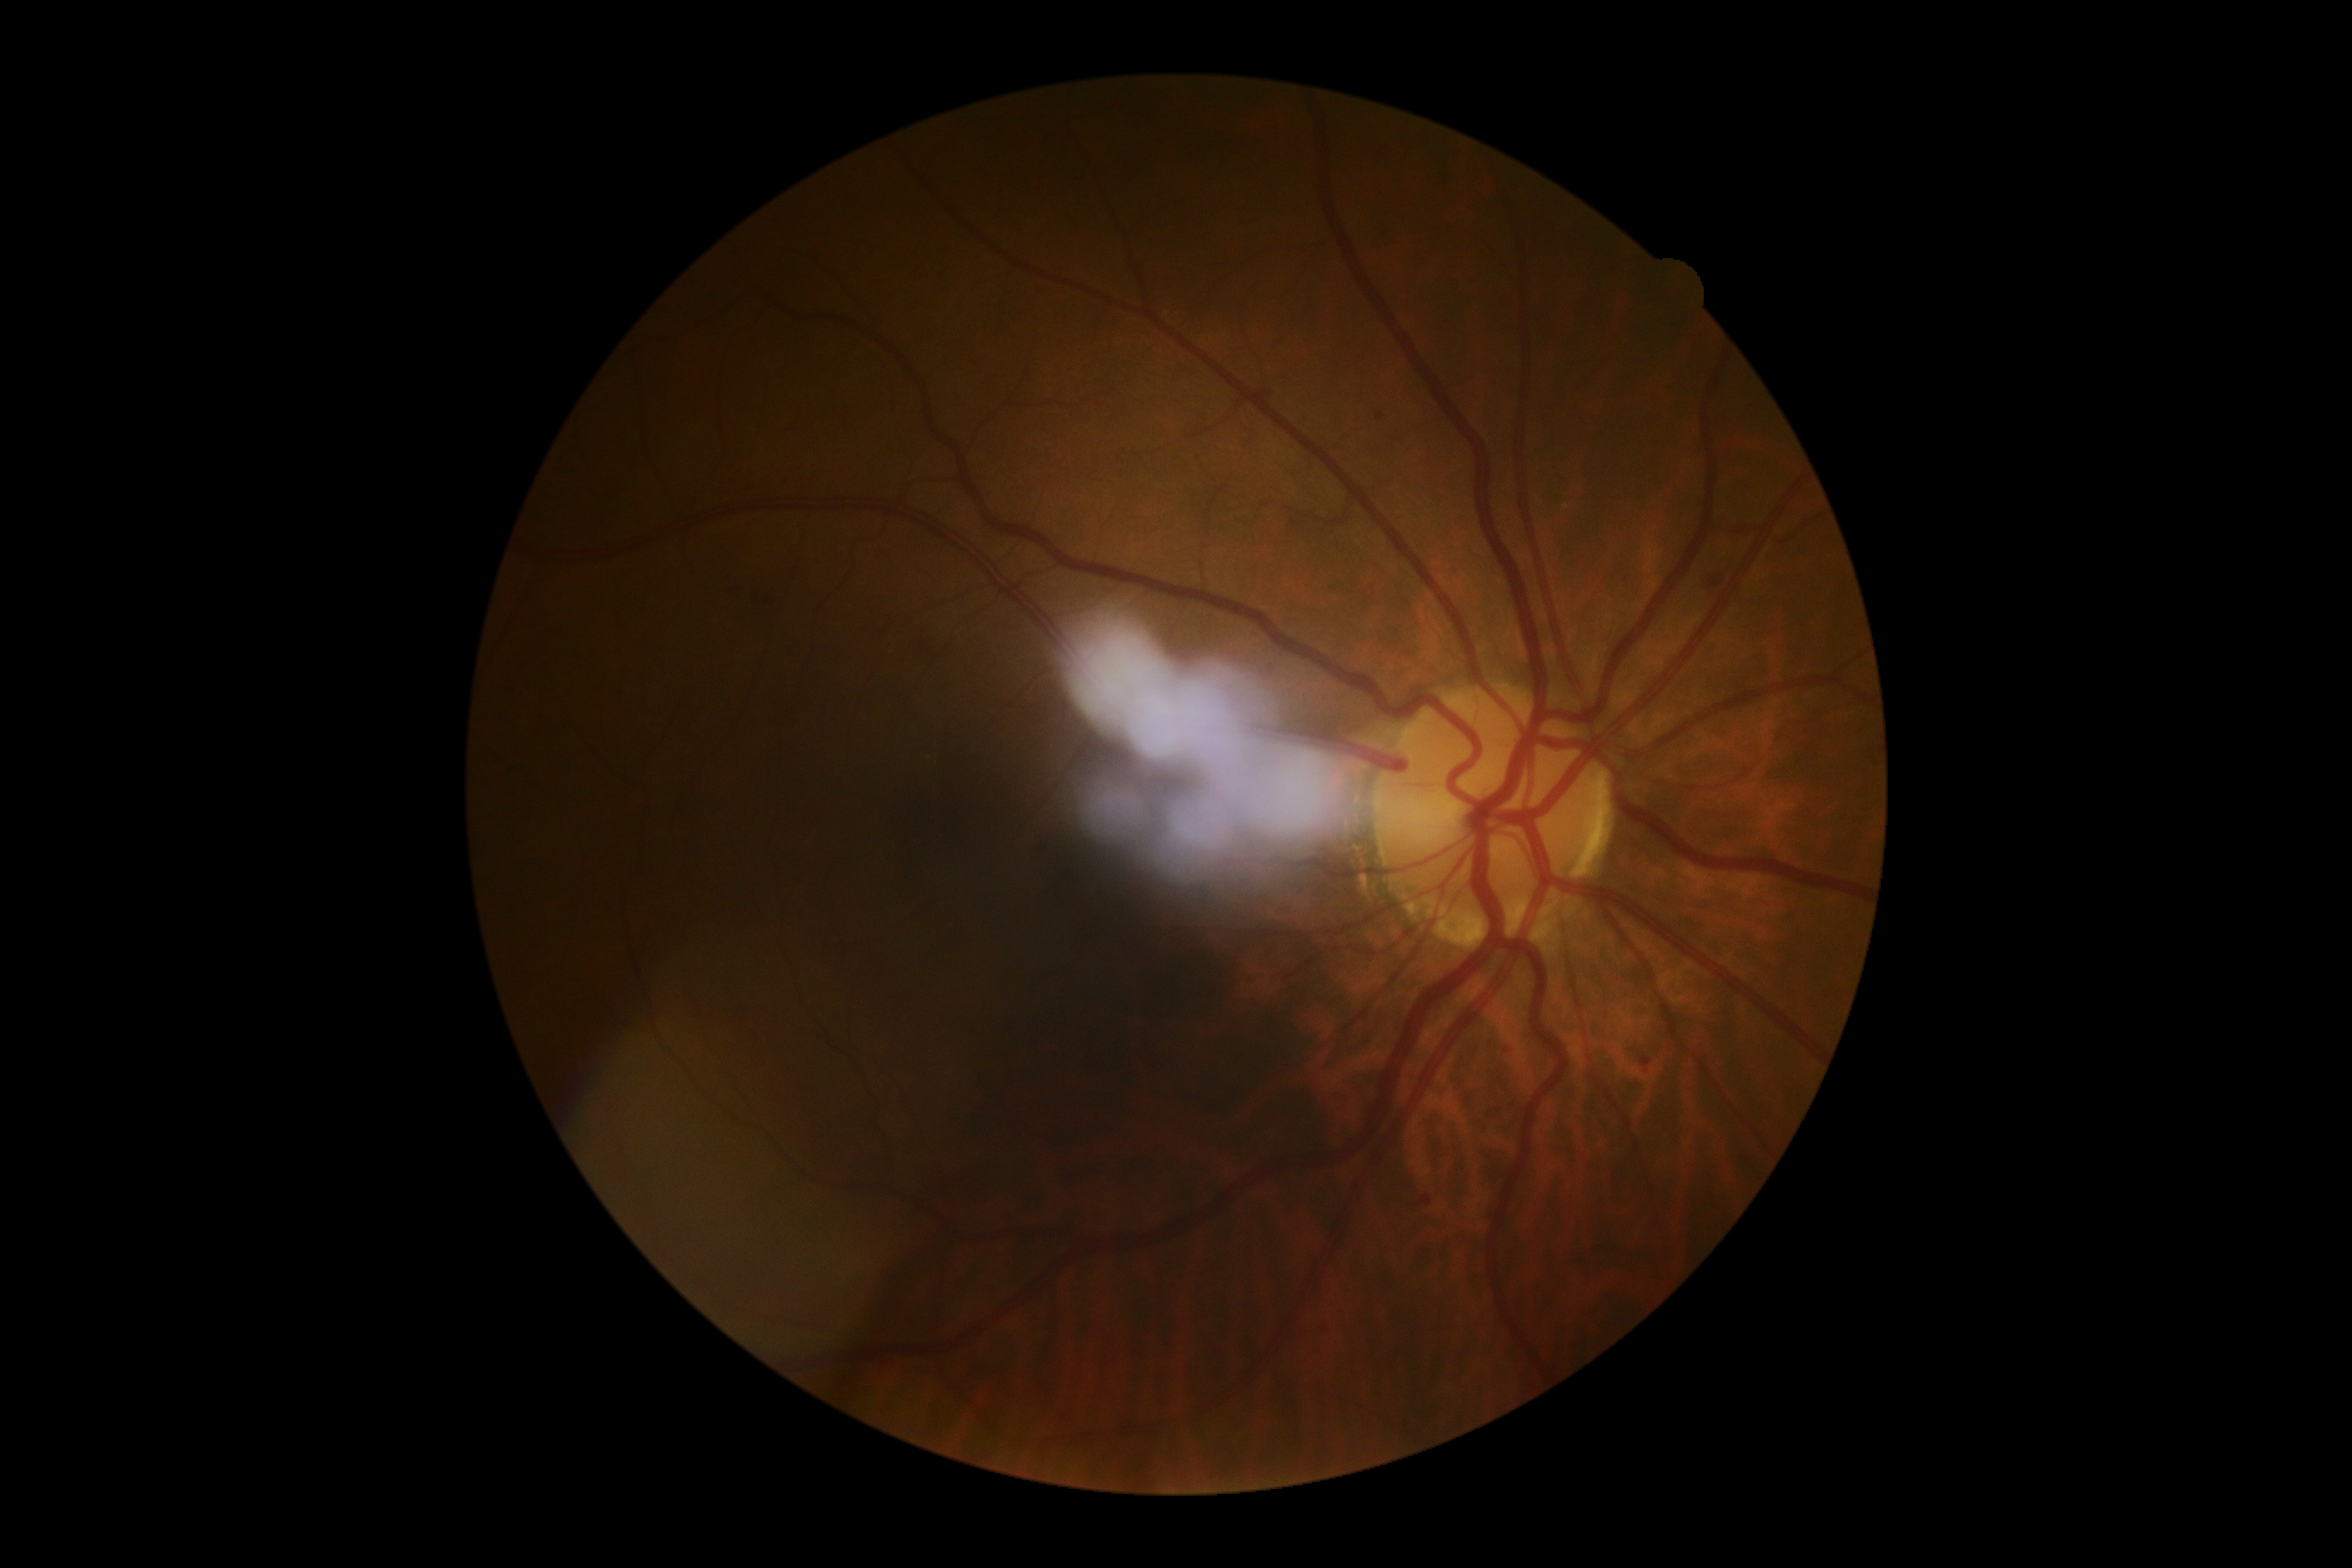

The retinopathy is classified as non-proliferative diabetic retinopathy.
DR severity: moderate NPDR (grade 2).